Acquired with a NIDEK AFC-230; without pupil dilation.
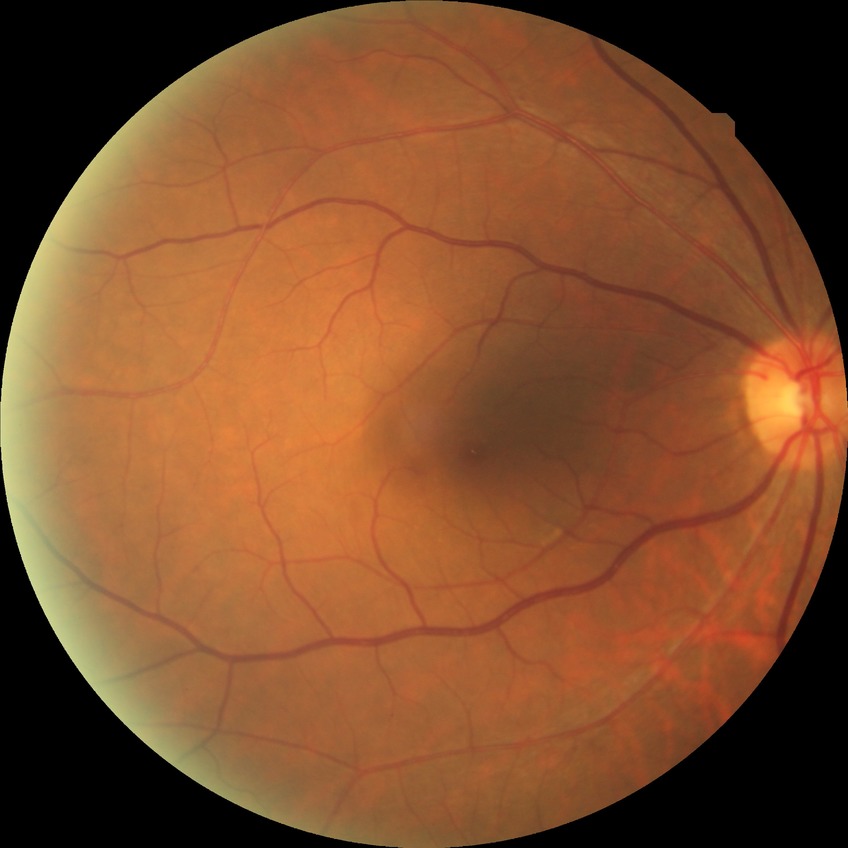
Diabetic retinopathy (DR): SDR (simple diabetic retinopathy).